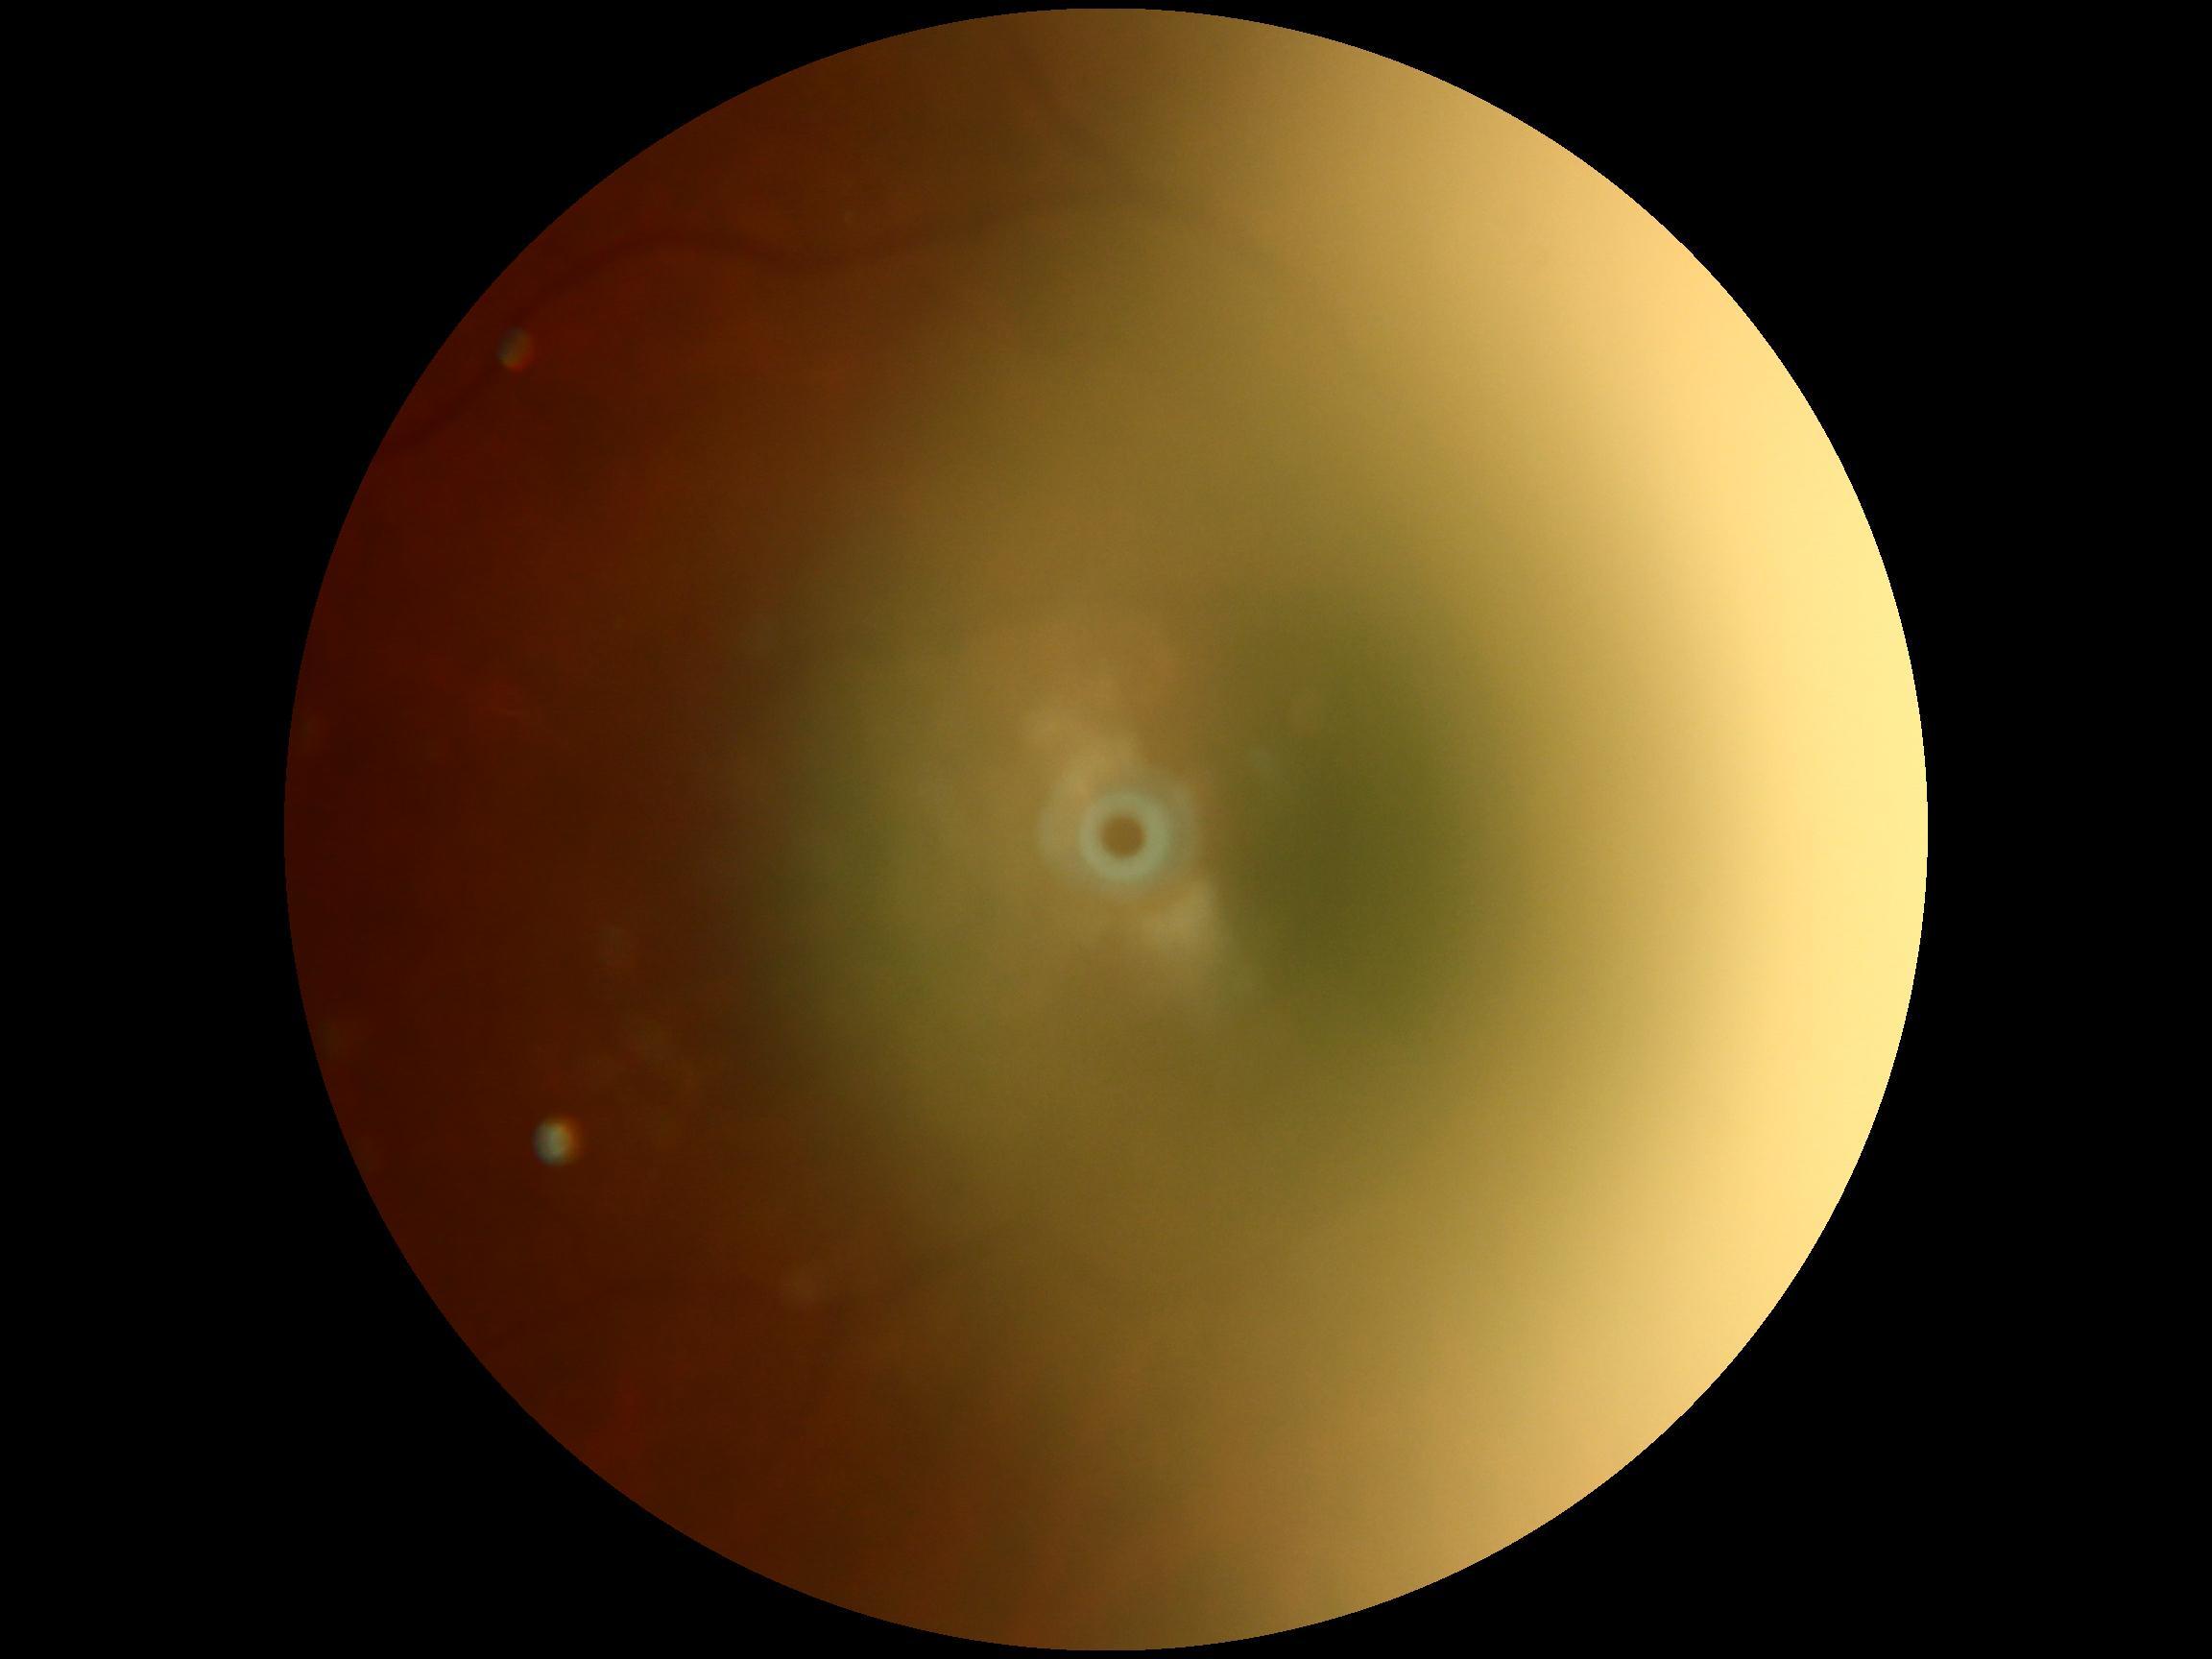 Ungradable image — DR severity cannot be determined. DR severity: ungradable.